2352x1568px — 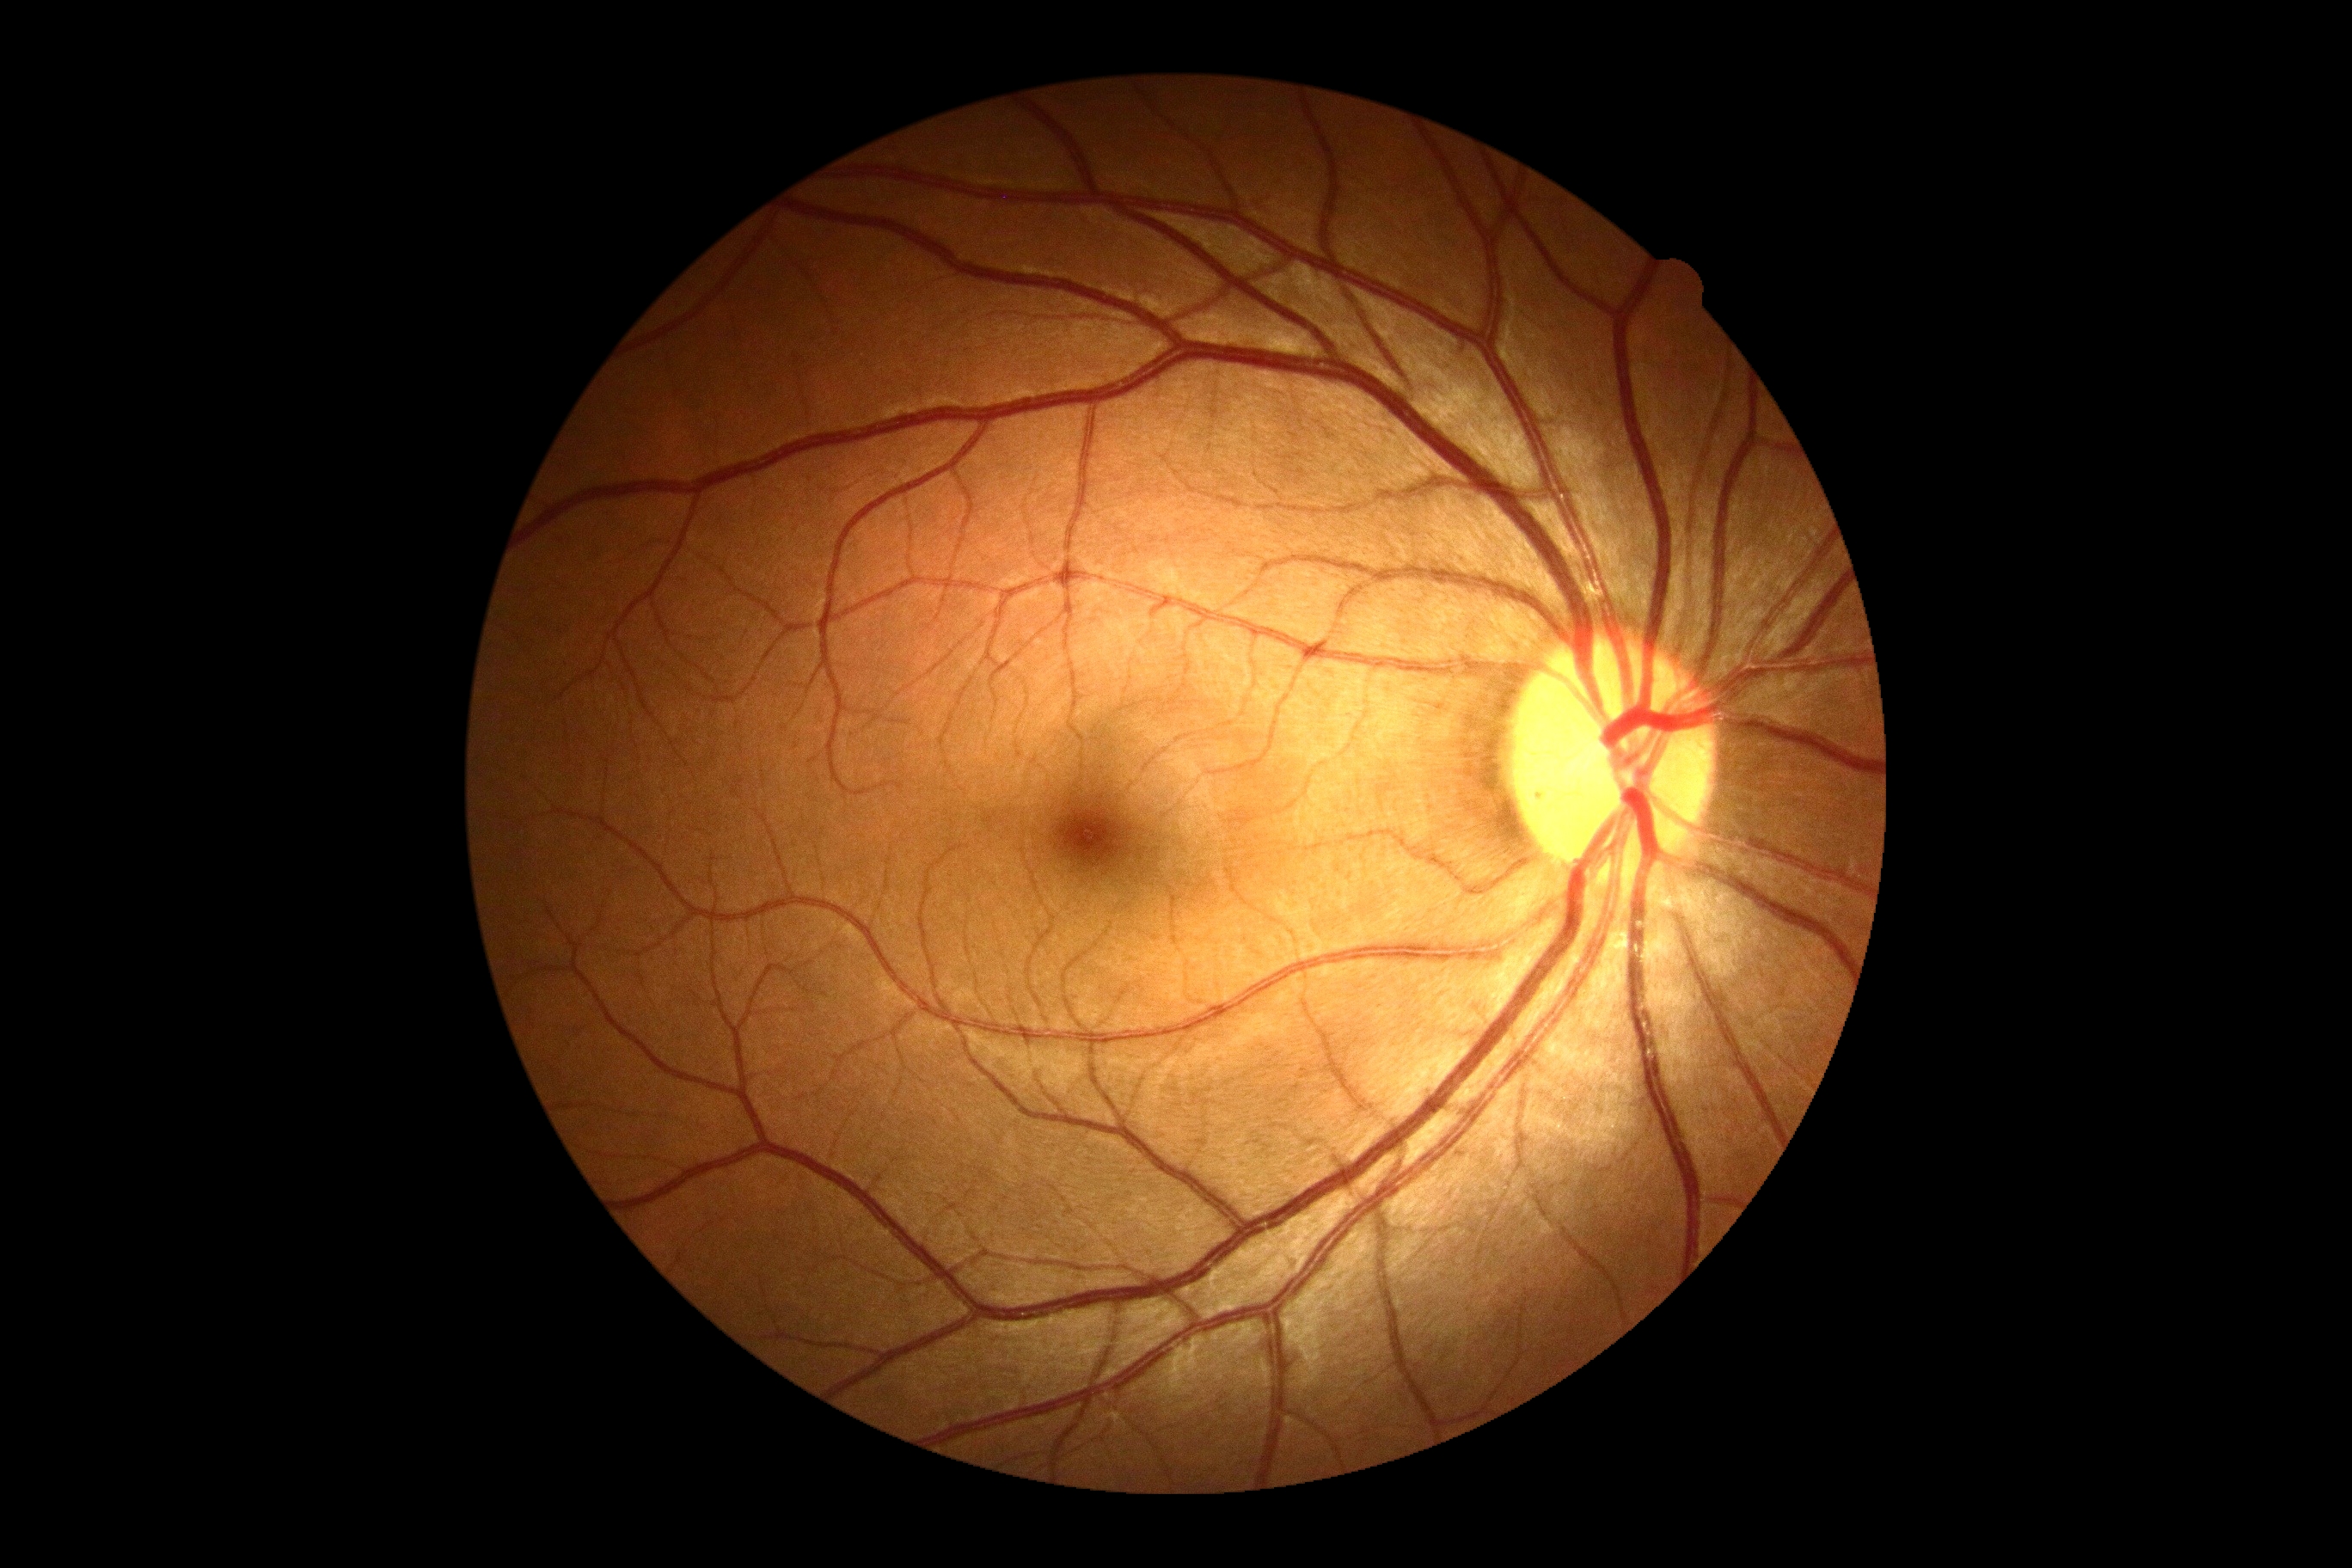 Diabetic retinopathy (DR) is no apparent diabetic retinopathy (grade 0).